Retinal fundus photograph. Optic disc region crop:
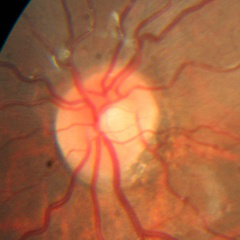 Demonstrates no glaucomatous findings.